RetCam wide-field infant fundus image: 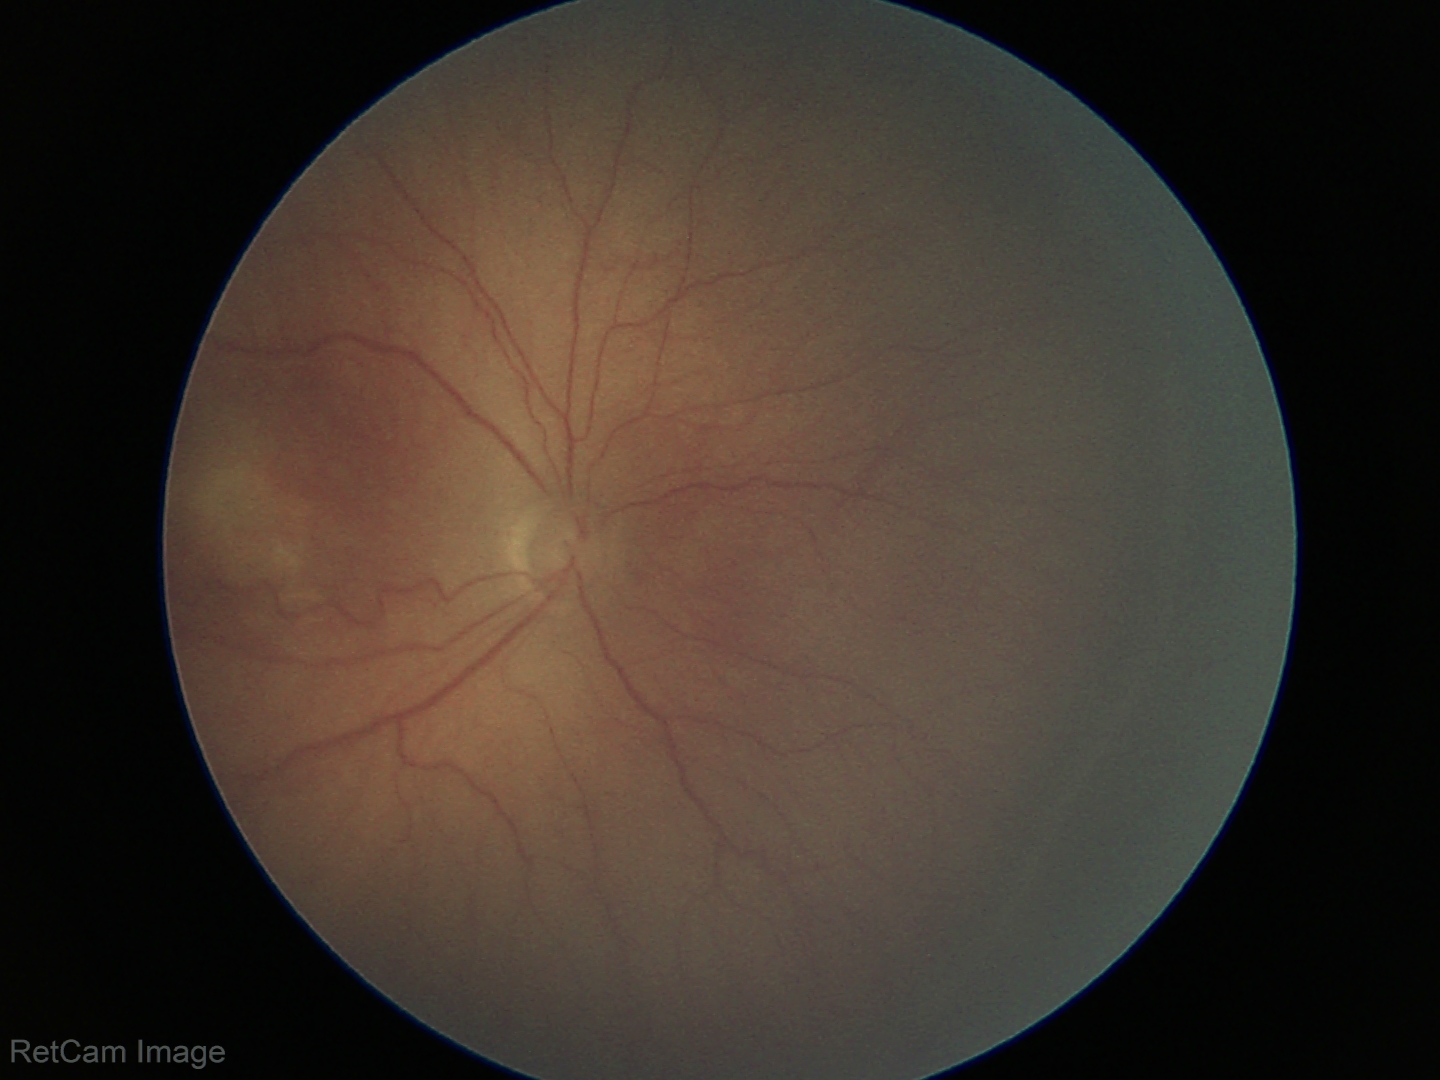
Diagnosis from this screening exam: retinopathy of prematurity (ROP) stage 3. Plus disease absent.